Captured on a Kowa VX-10α fundus camera. Macula-centered field. 2361 x 1568 pixels
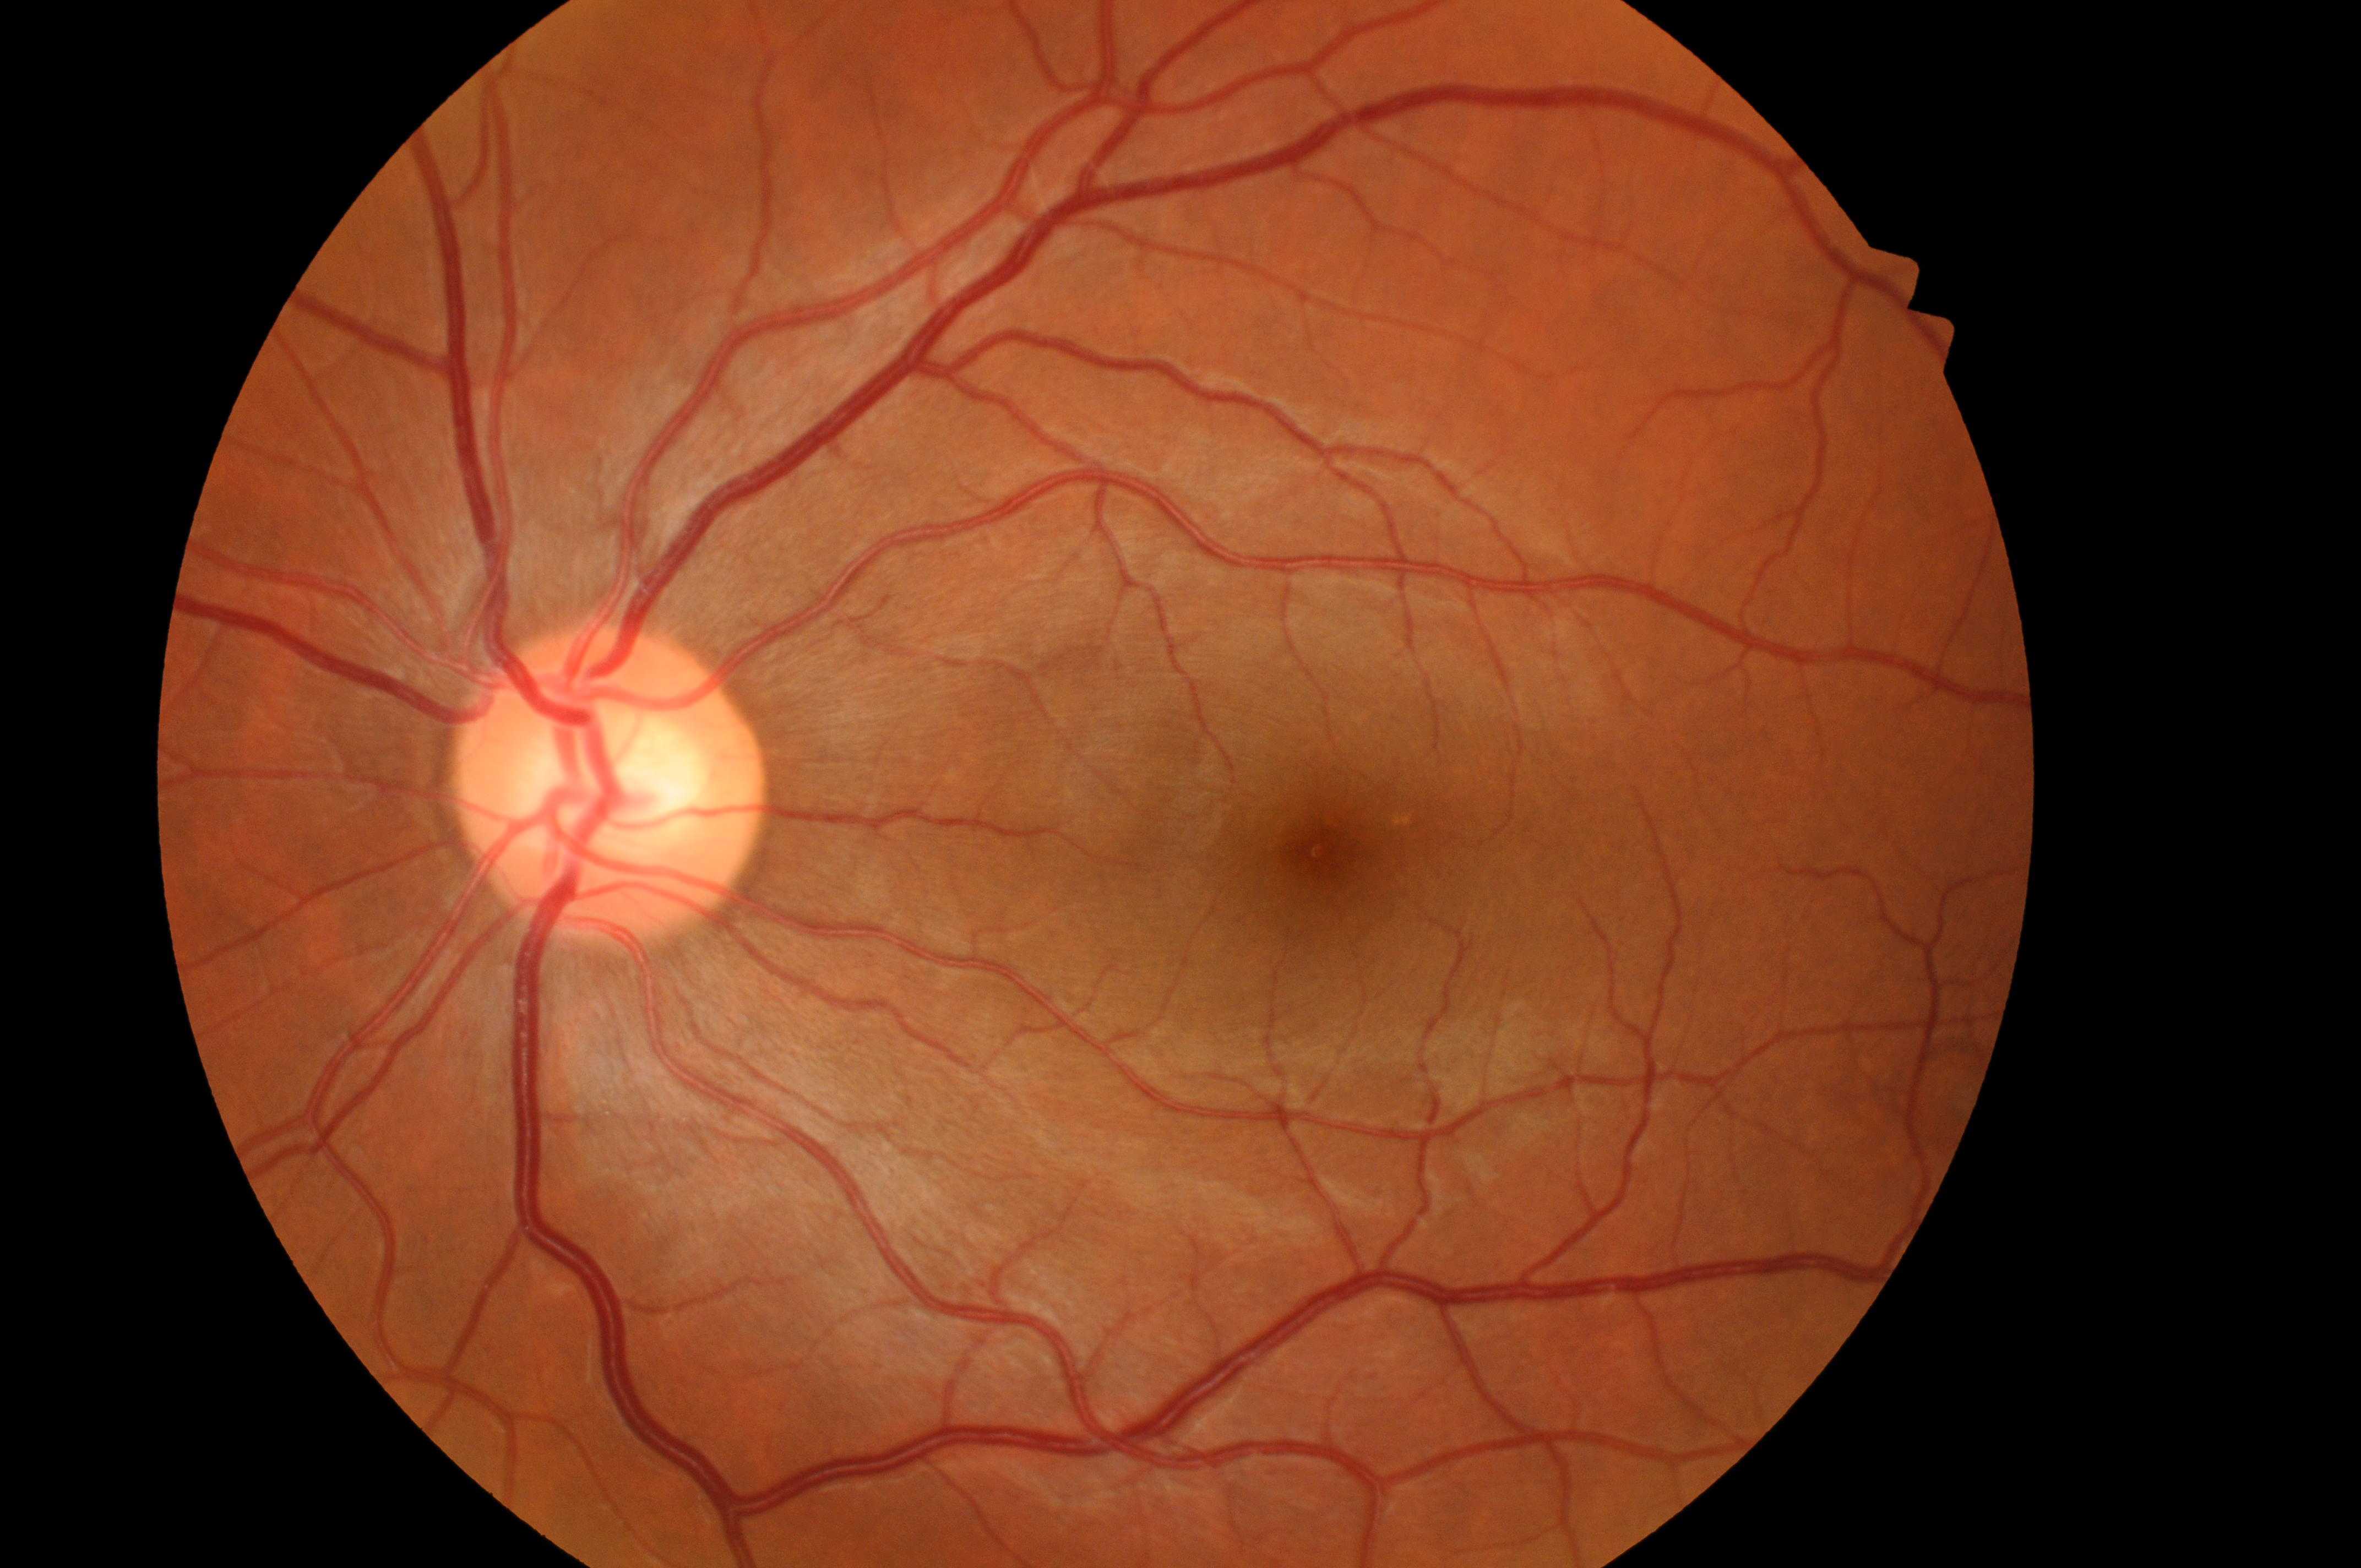

DME grade: 0 (no risk). Optic disc: (x=600, y=798). DR stage: no apparent diabetic retinopathy (grade 0). The image shows the left eye. The macula center is at (x=1324, y=850).